Infant wide-field retinal image — 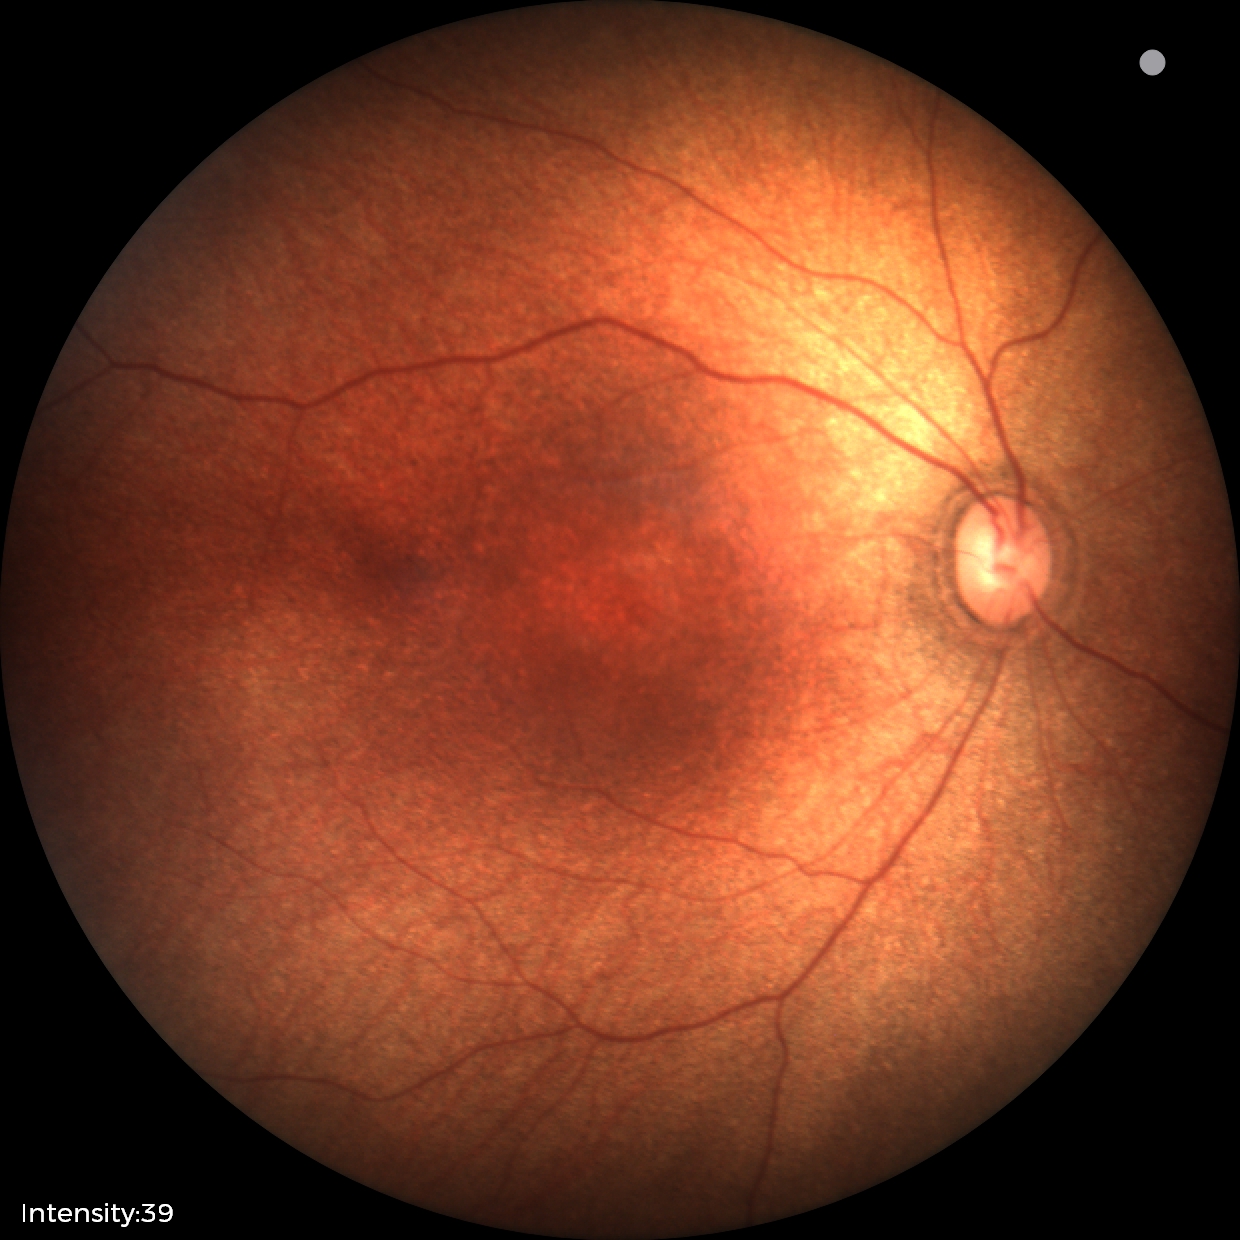
Physiological retinal appearance for postconceptual age.